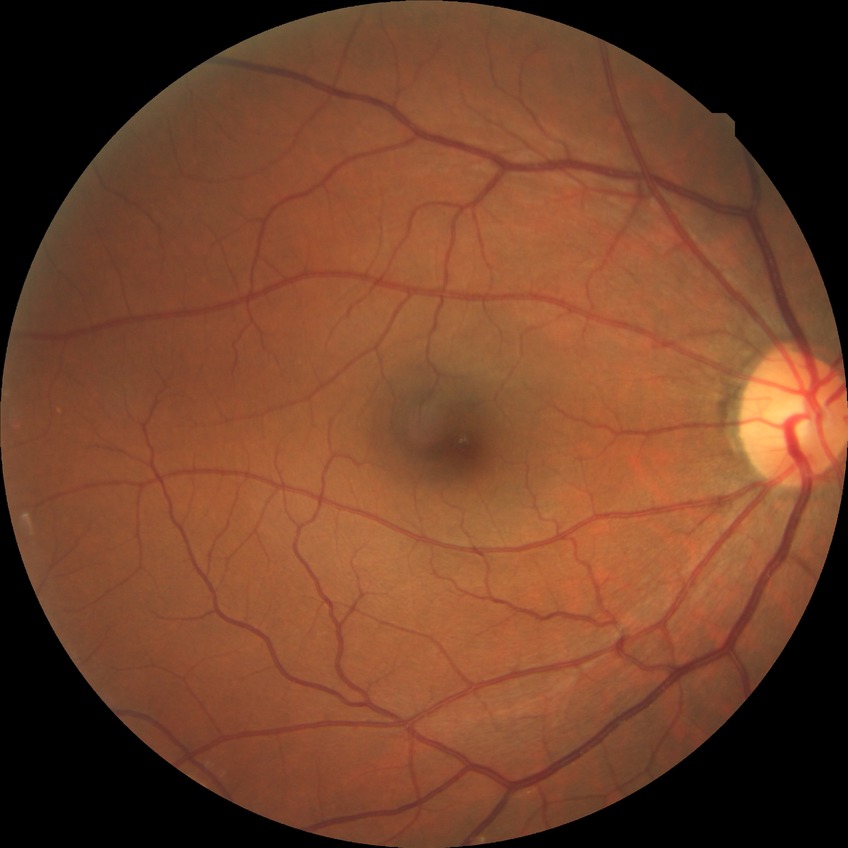
davis_grade: no diabetic retinopathy